Modified Davis classification: 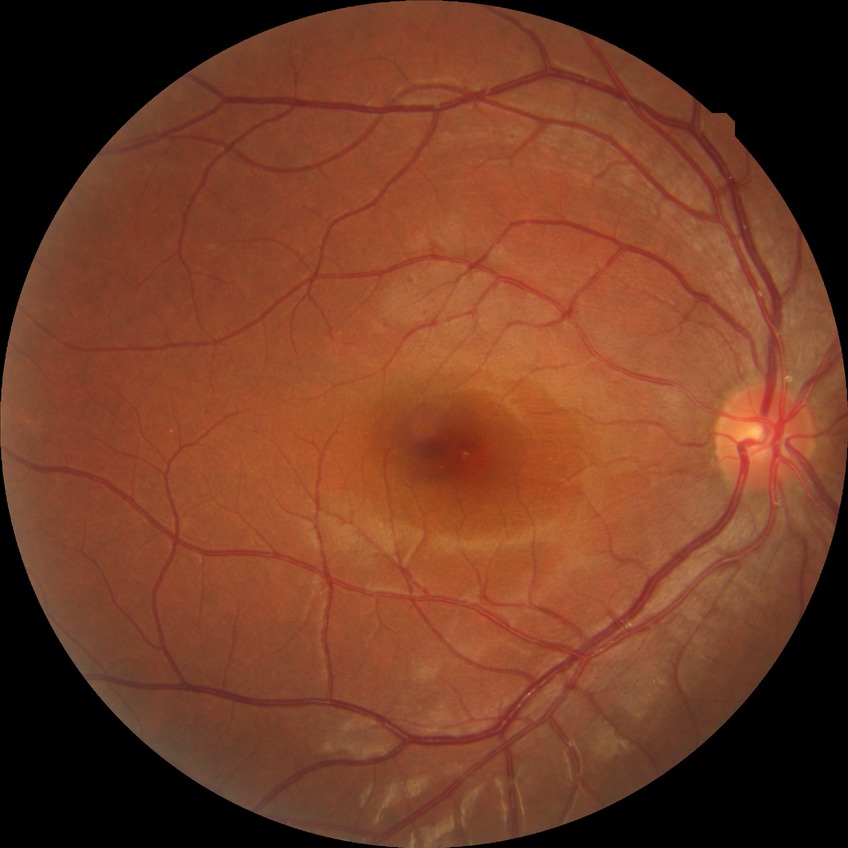
Diabetic retinopathy (DR) is simple diabetic retinopathy (SDR).